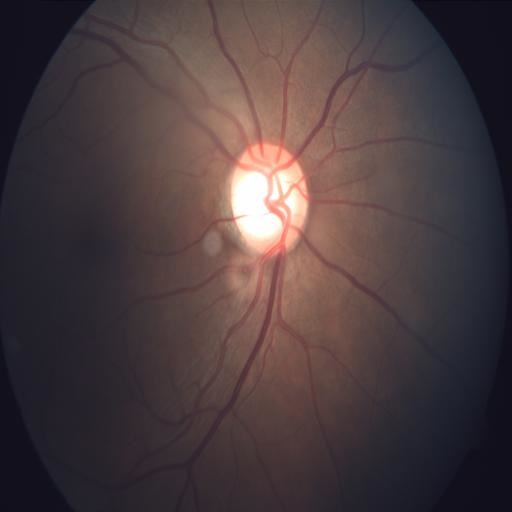 Pathology: ODP (optic disc pallor).